Retinal fundus photograph: 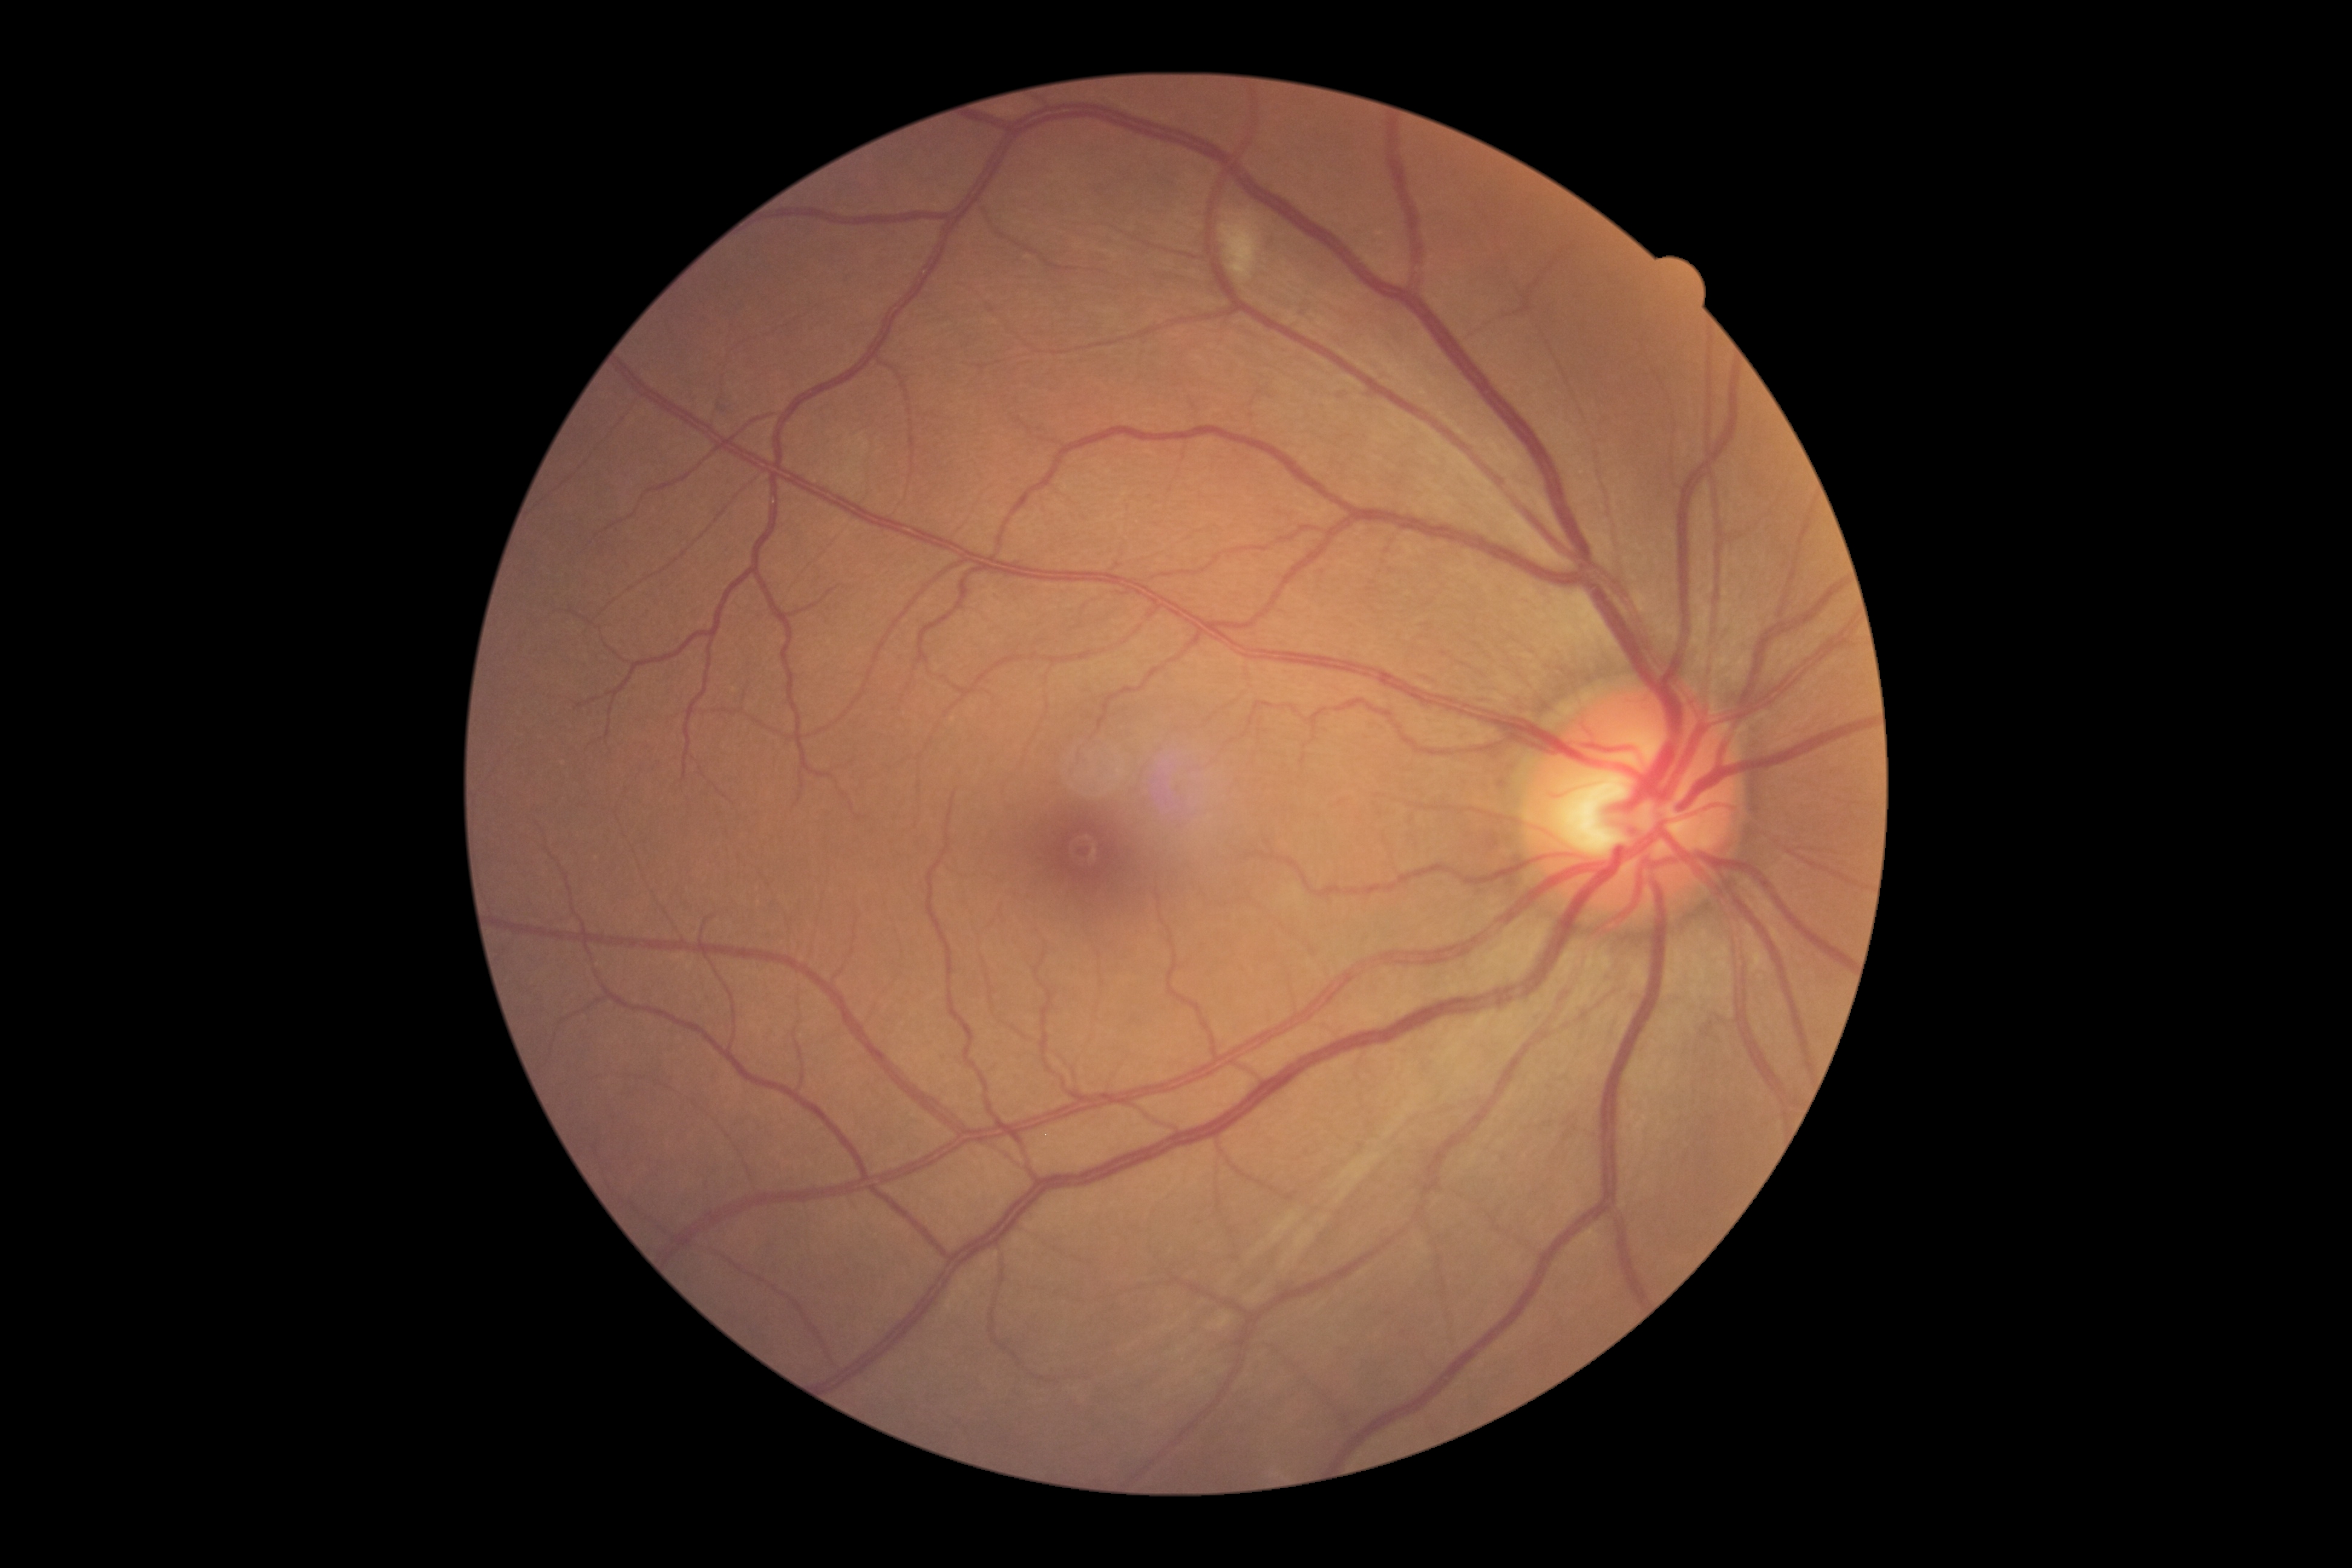
DR severity: grade 2. Disease class: non-proliferative diabetic retinopathy.